Optic nerve head crop · retinal fundus photograph · non-mydriatic acquisition: 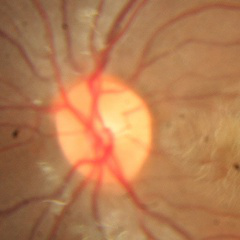

No glaucomatous optic neuropathy.